Modified Davis grading:
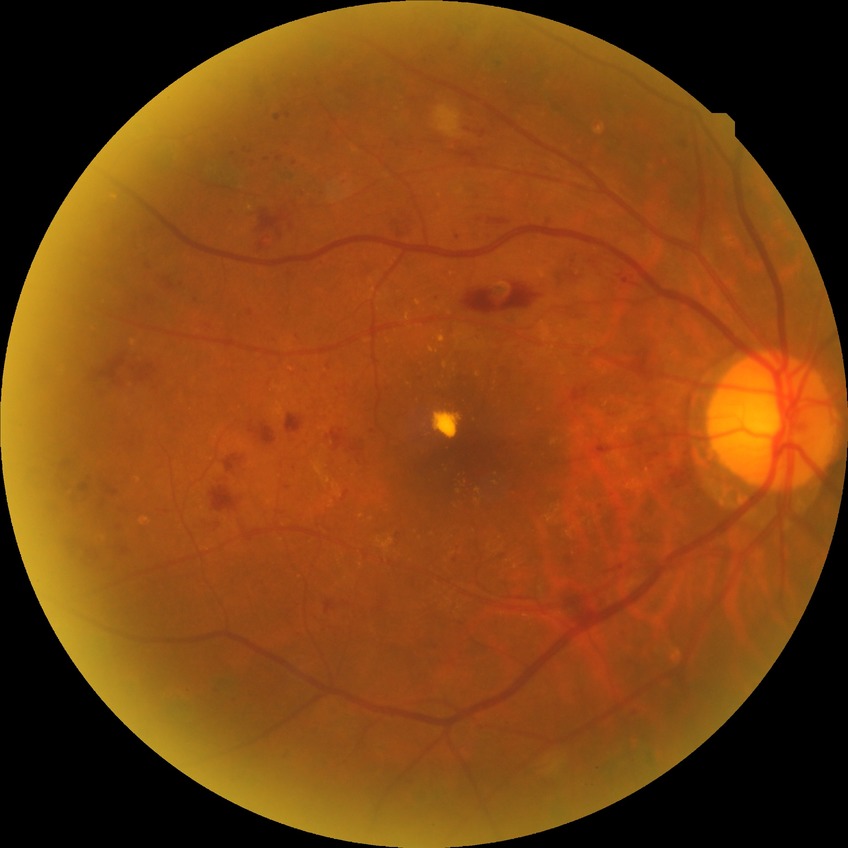 DR severity is PDR.